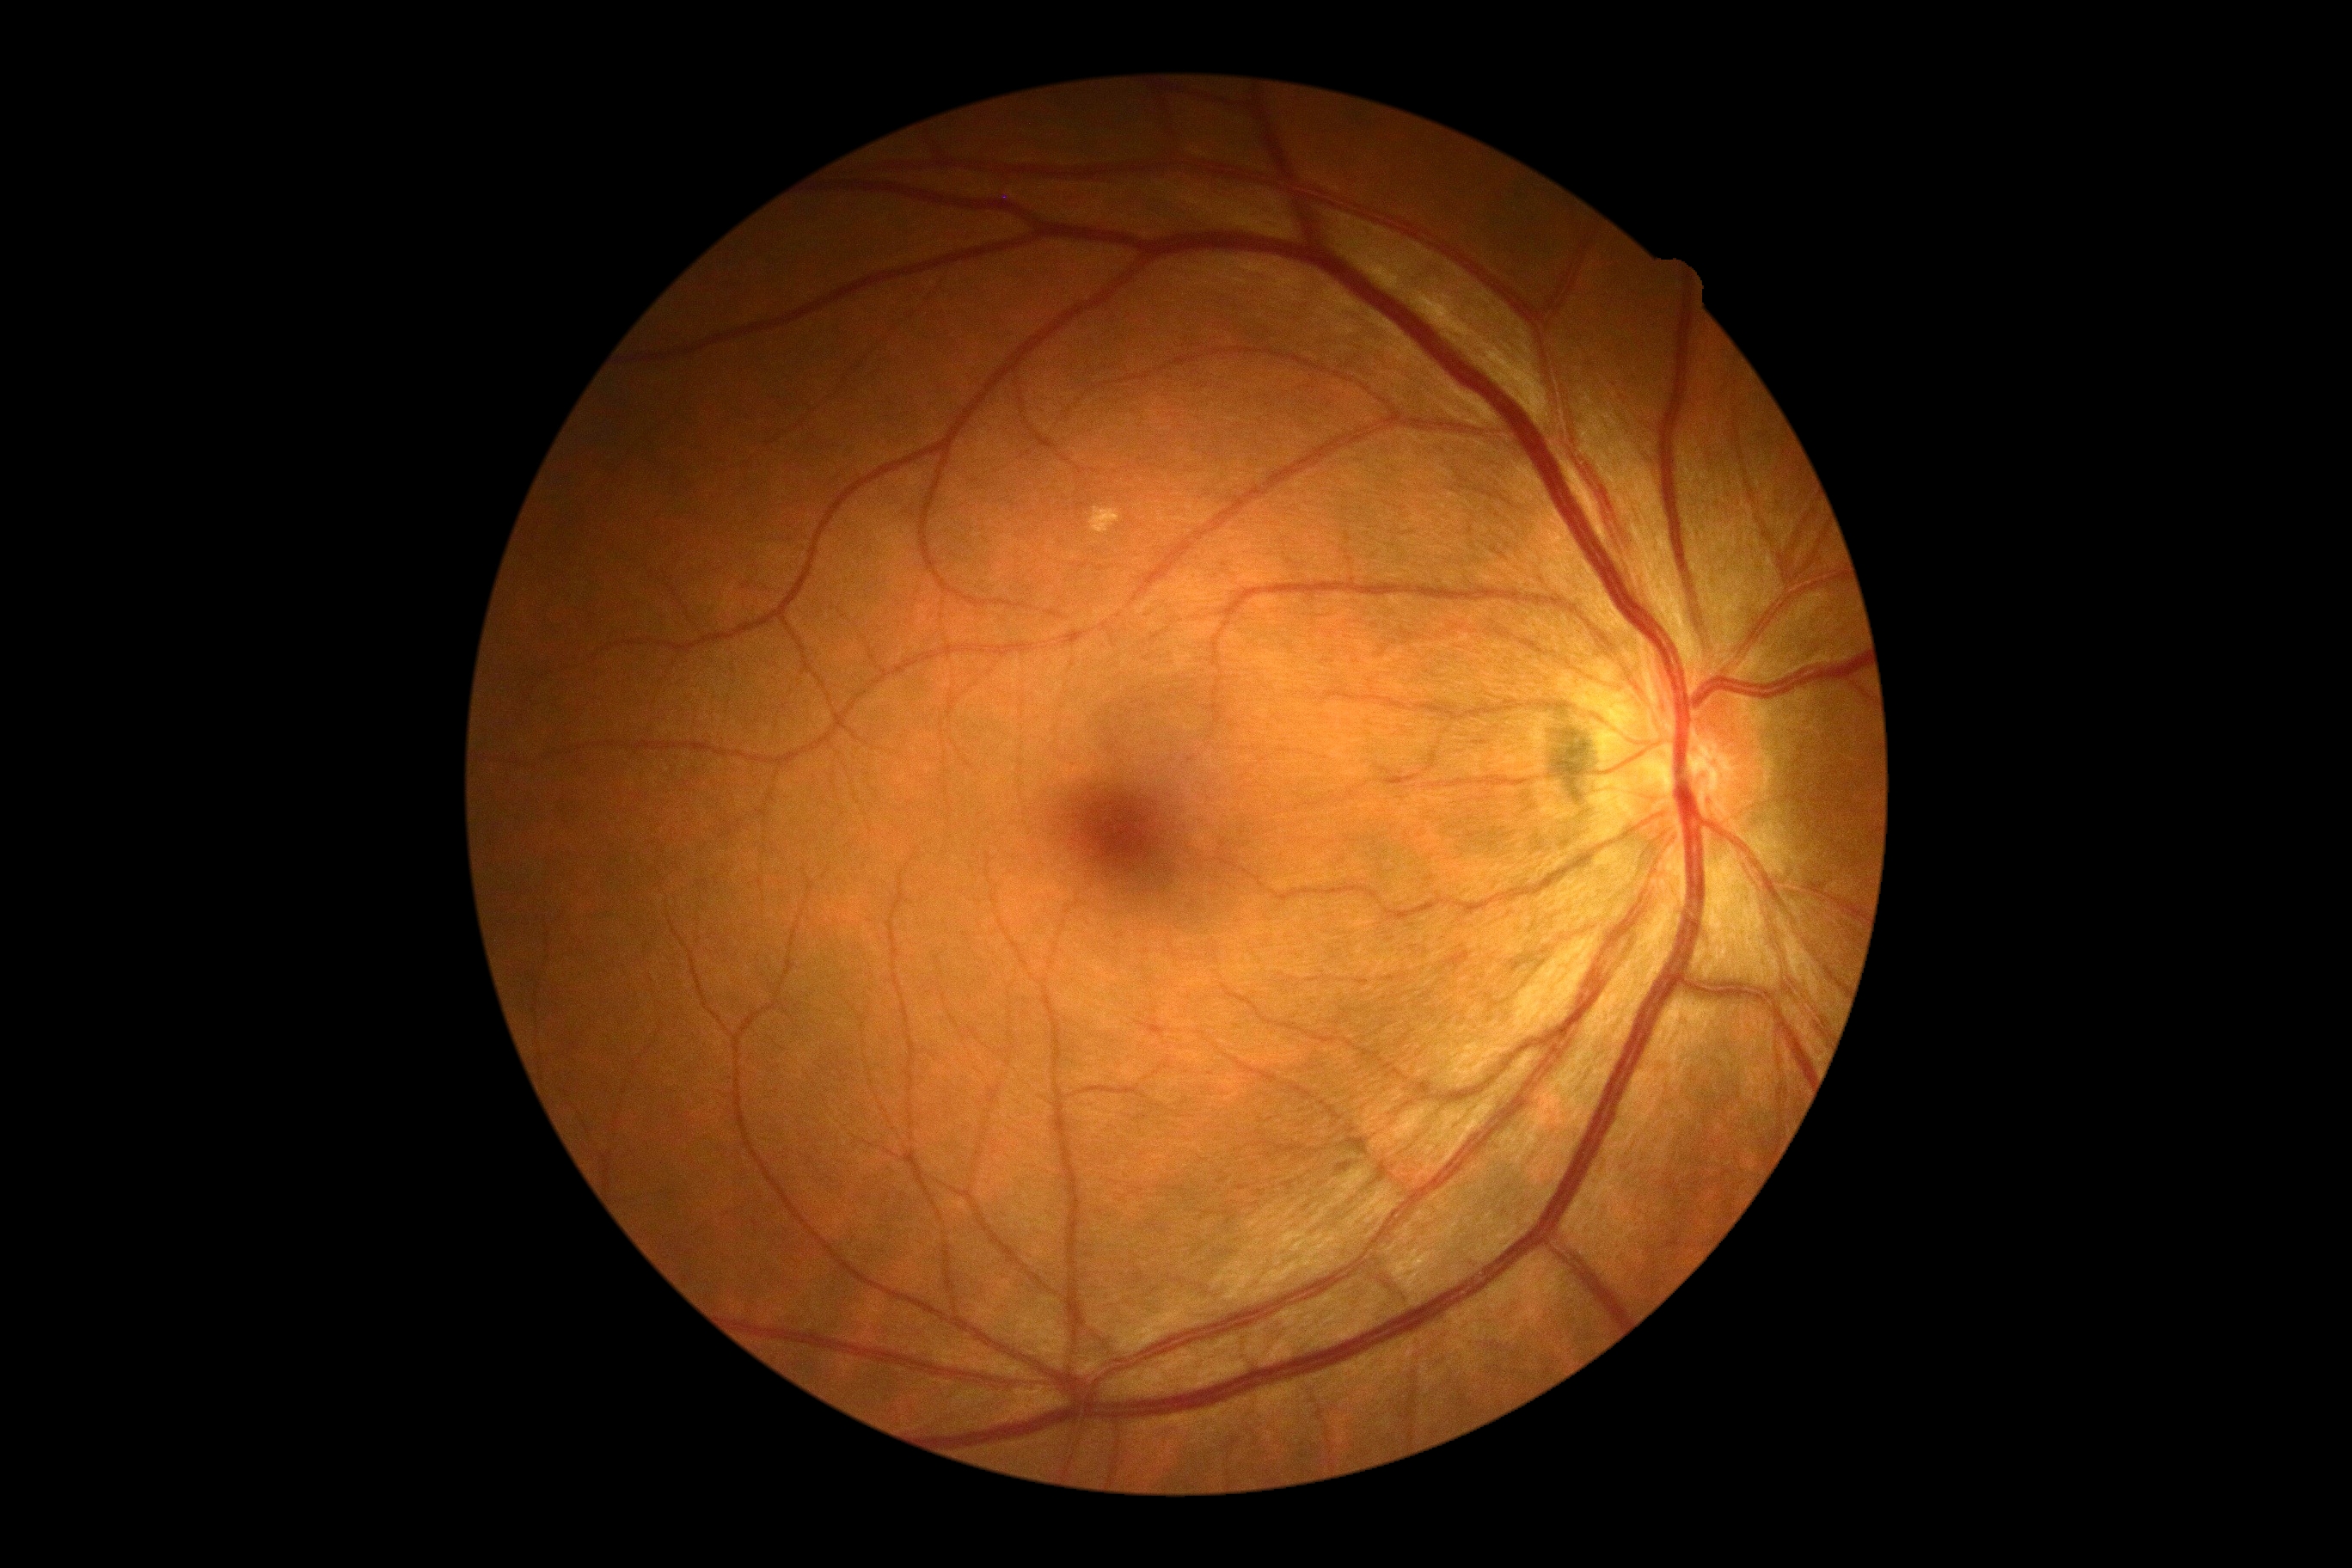
No apparent diabetic retinopathy.
Retinopathy grade: 0 (no apparent retinopathy).